Nonmydriatic fundus photograph. Davis DR grading: 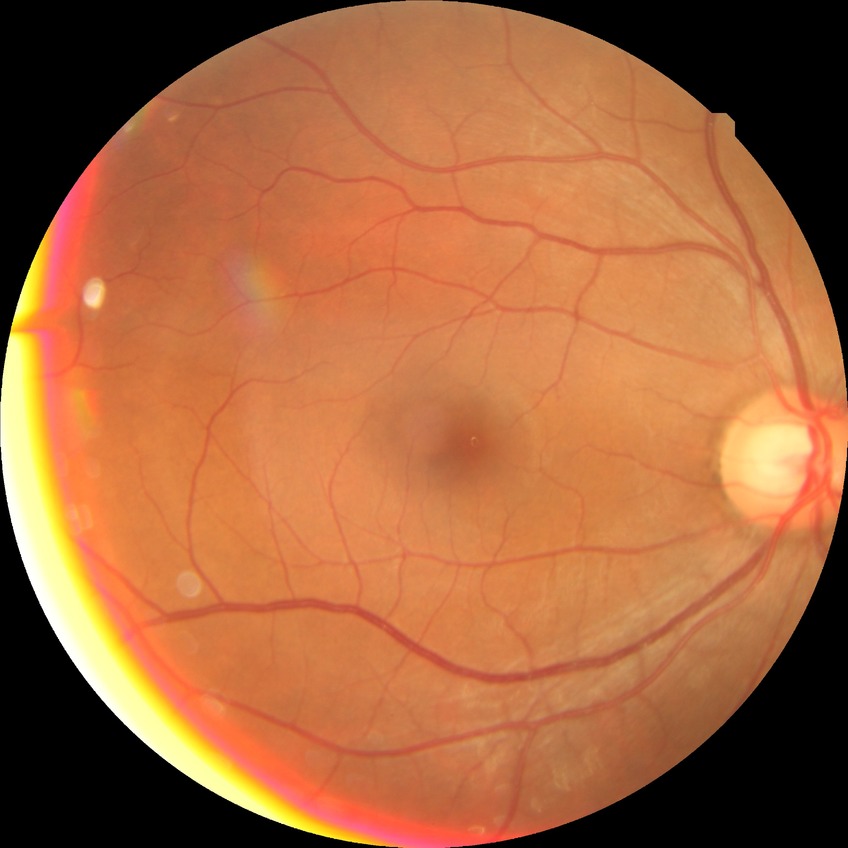
Diabetic retinopathy (DR): no diabetic retinopathy (NDR).